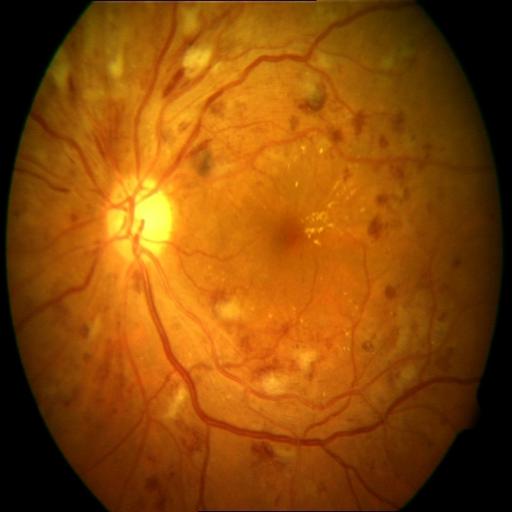

The image shows central retinal vein occlusion (CRVO).